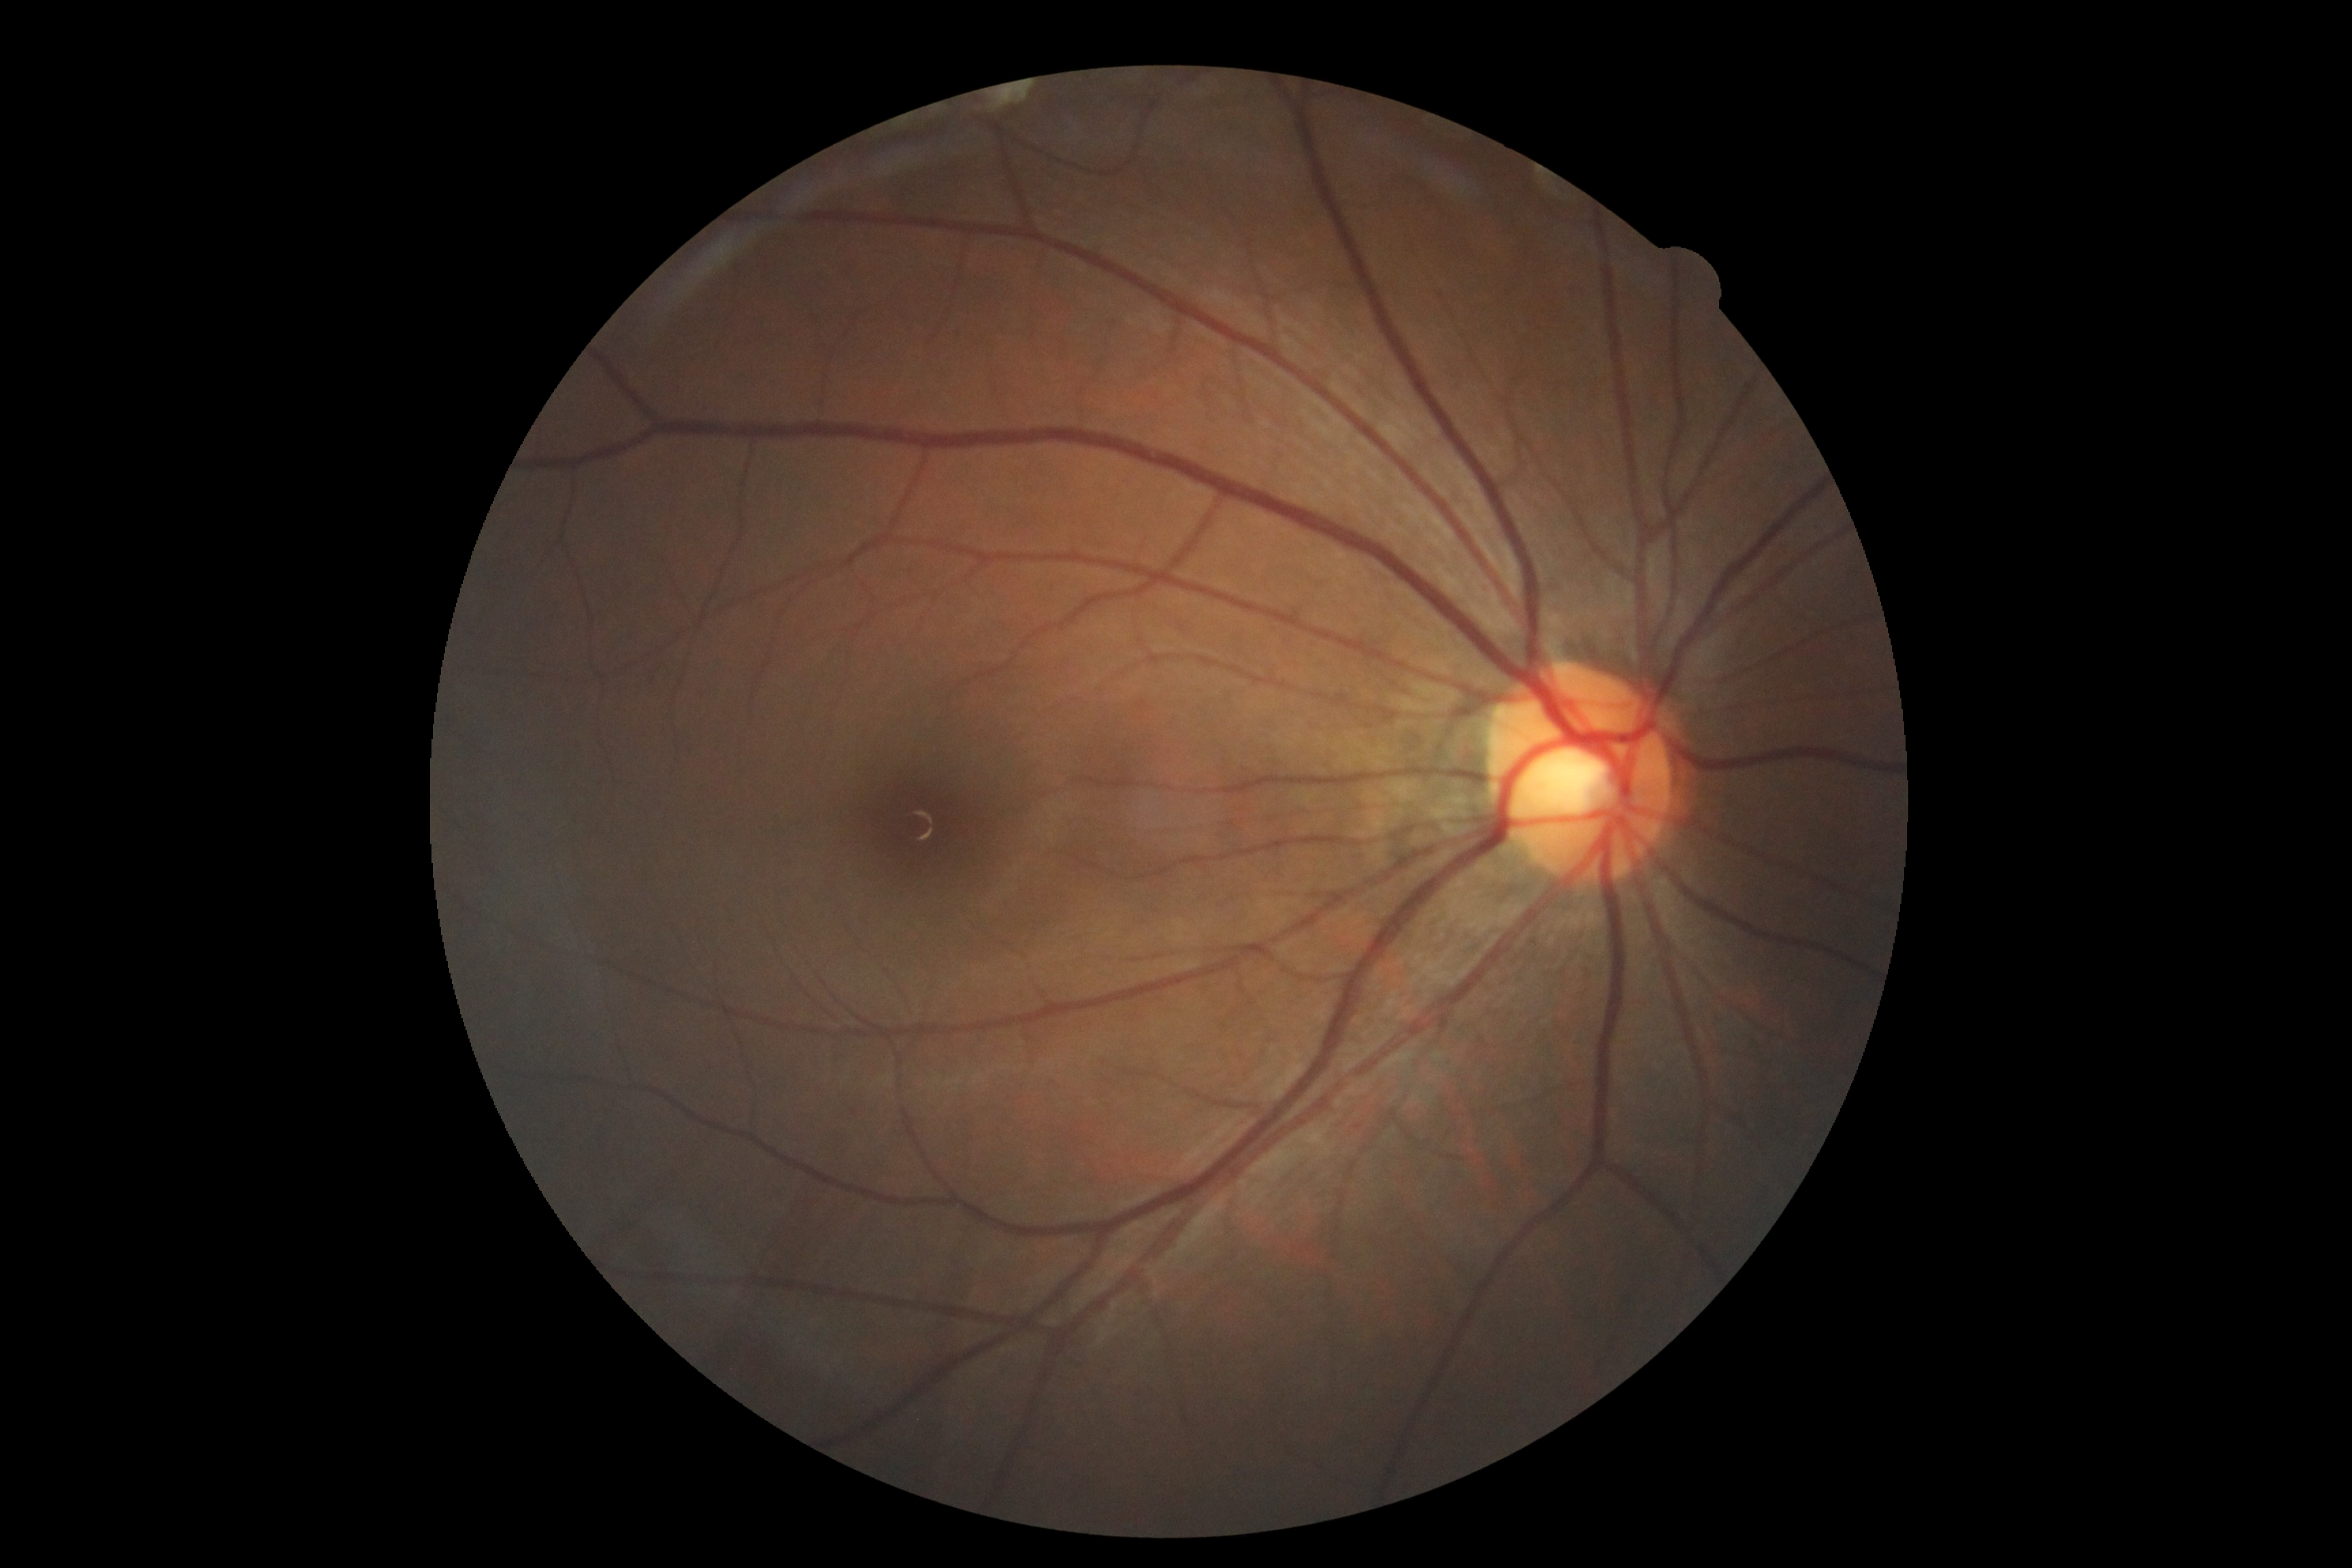
Retinopathy is no apparent retinopathy (grade 0).